Axial length: 23.09 mm. Sex: female. 57-year-old patient — 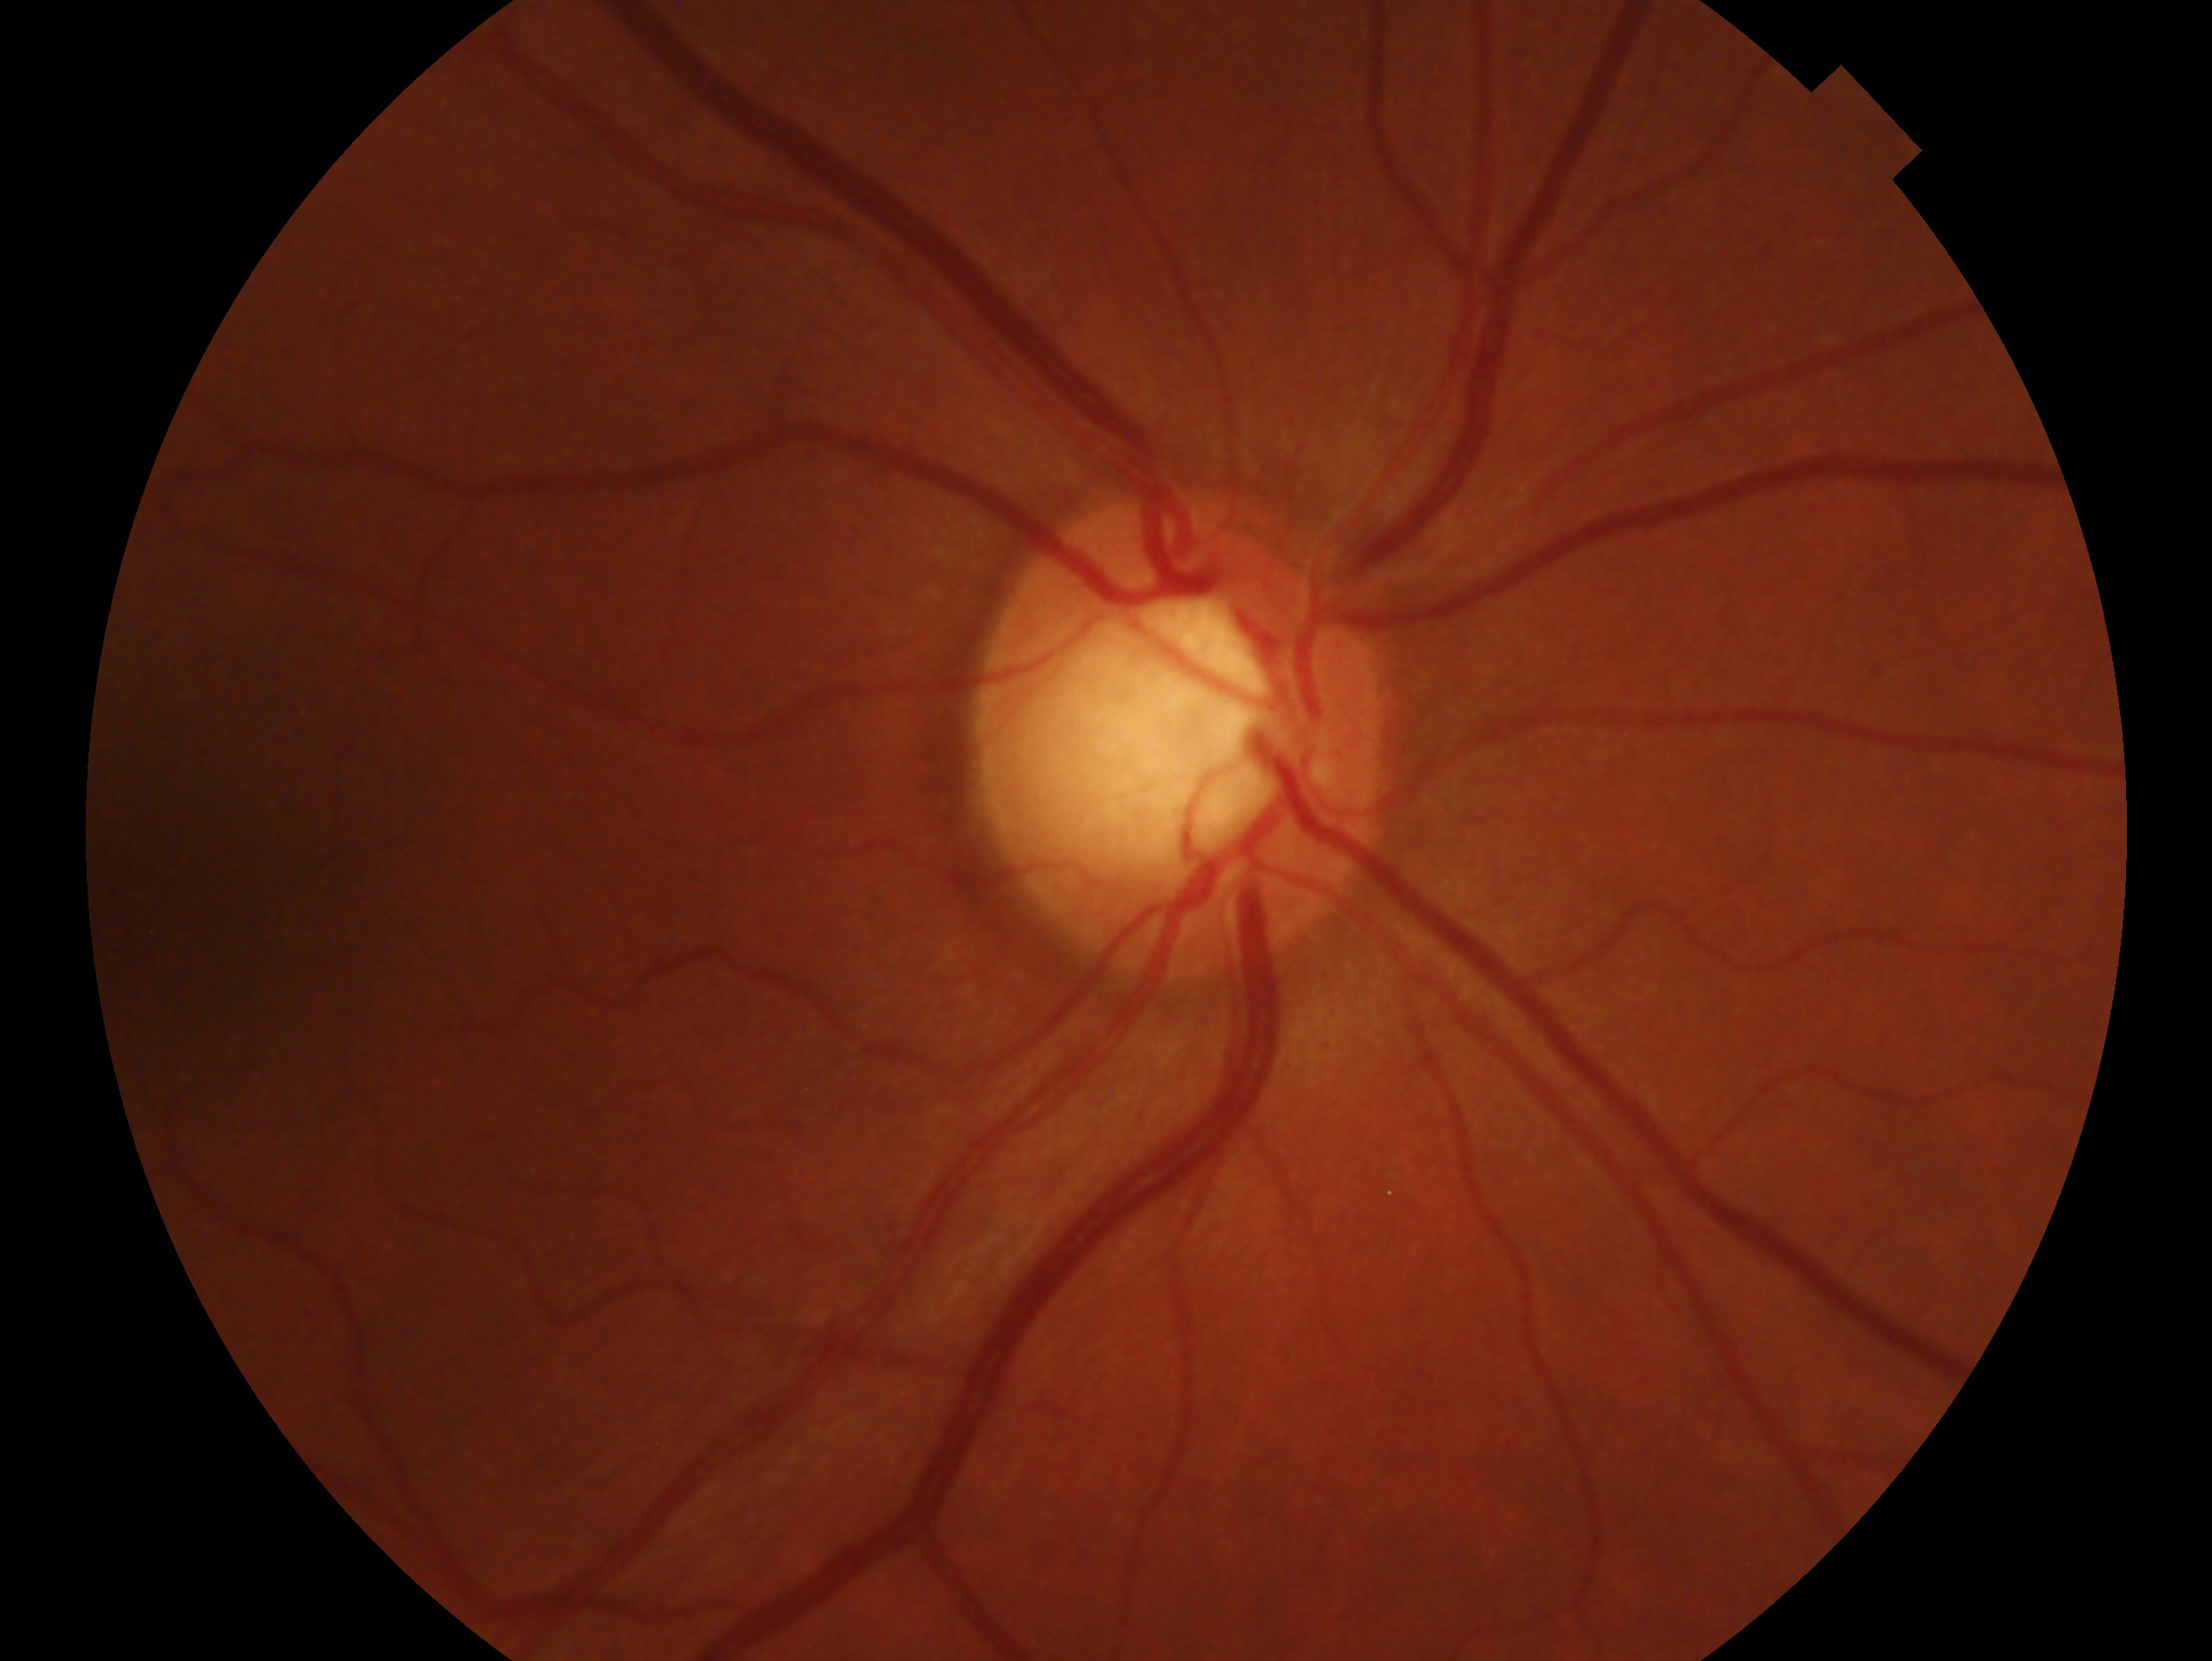 Glaucoma assessment — glaucomatous optic neuropathy. Imaged eye: right.